Fundus photo · 45 degree fundus photograph · without pupil dilation.
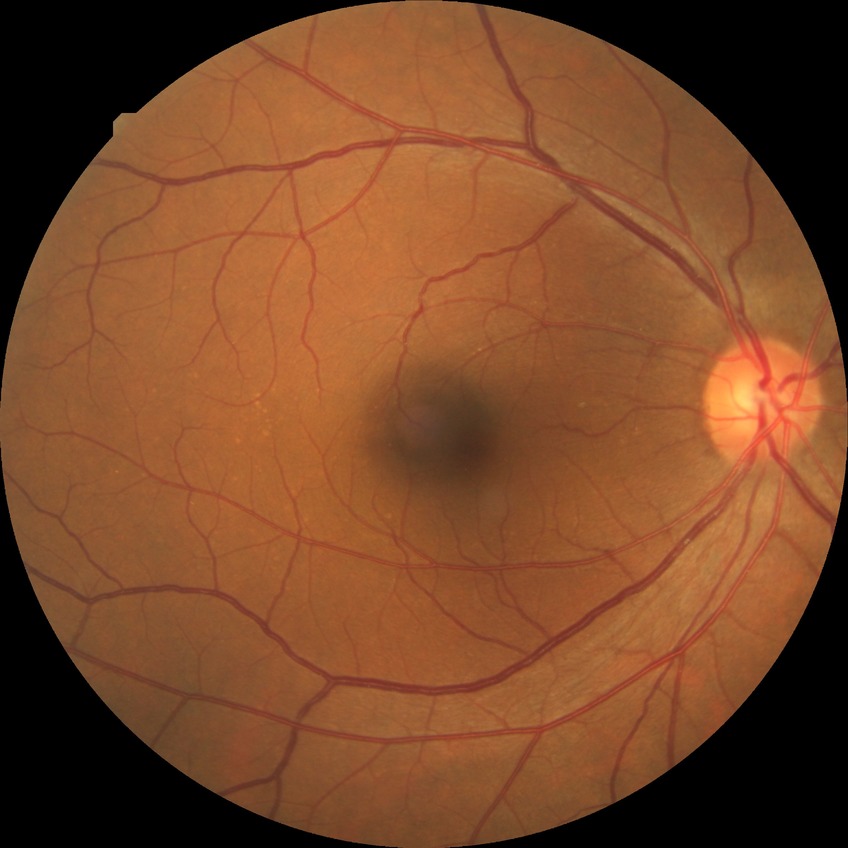 diabetic retinopathy (DR)=NDR (no diabetic retinopathy).